Captured after pupil dilation:
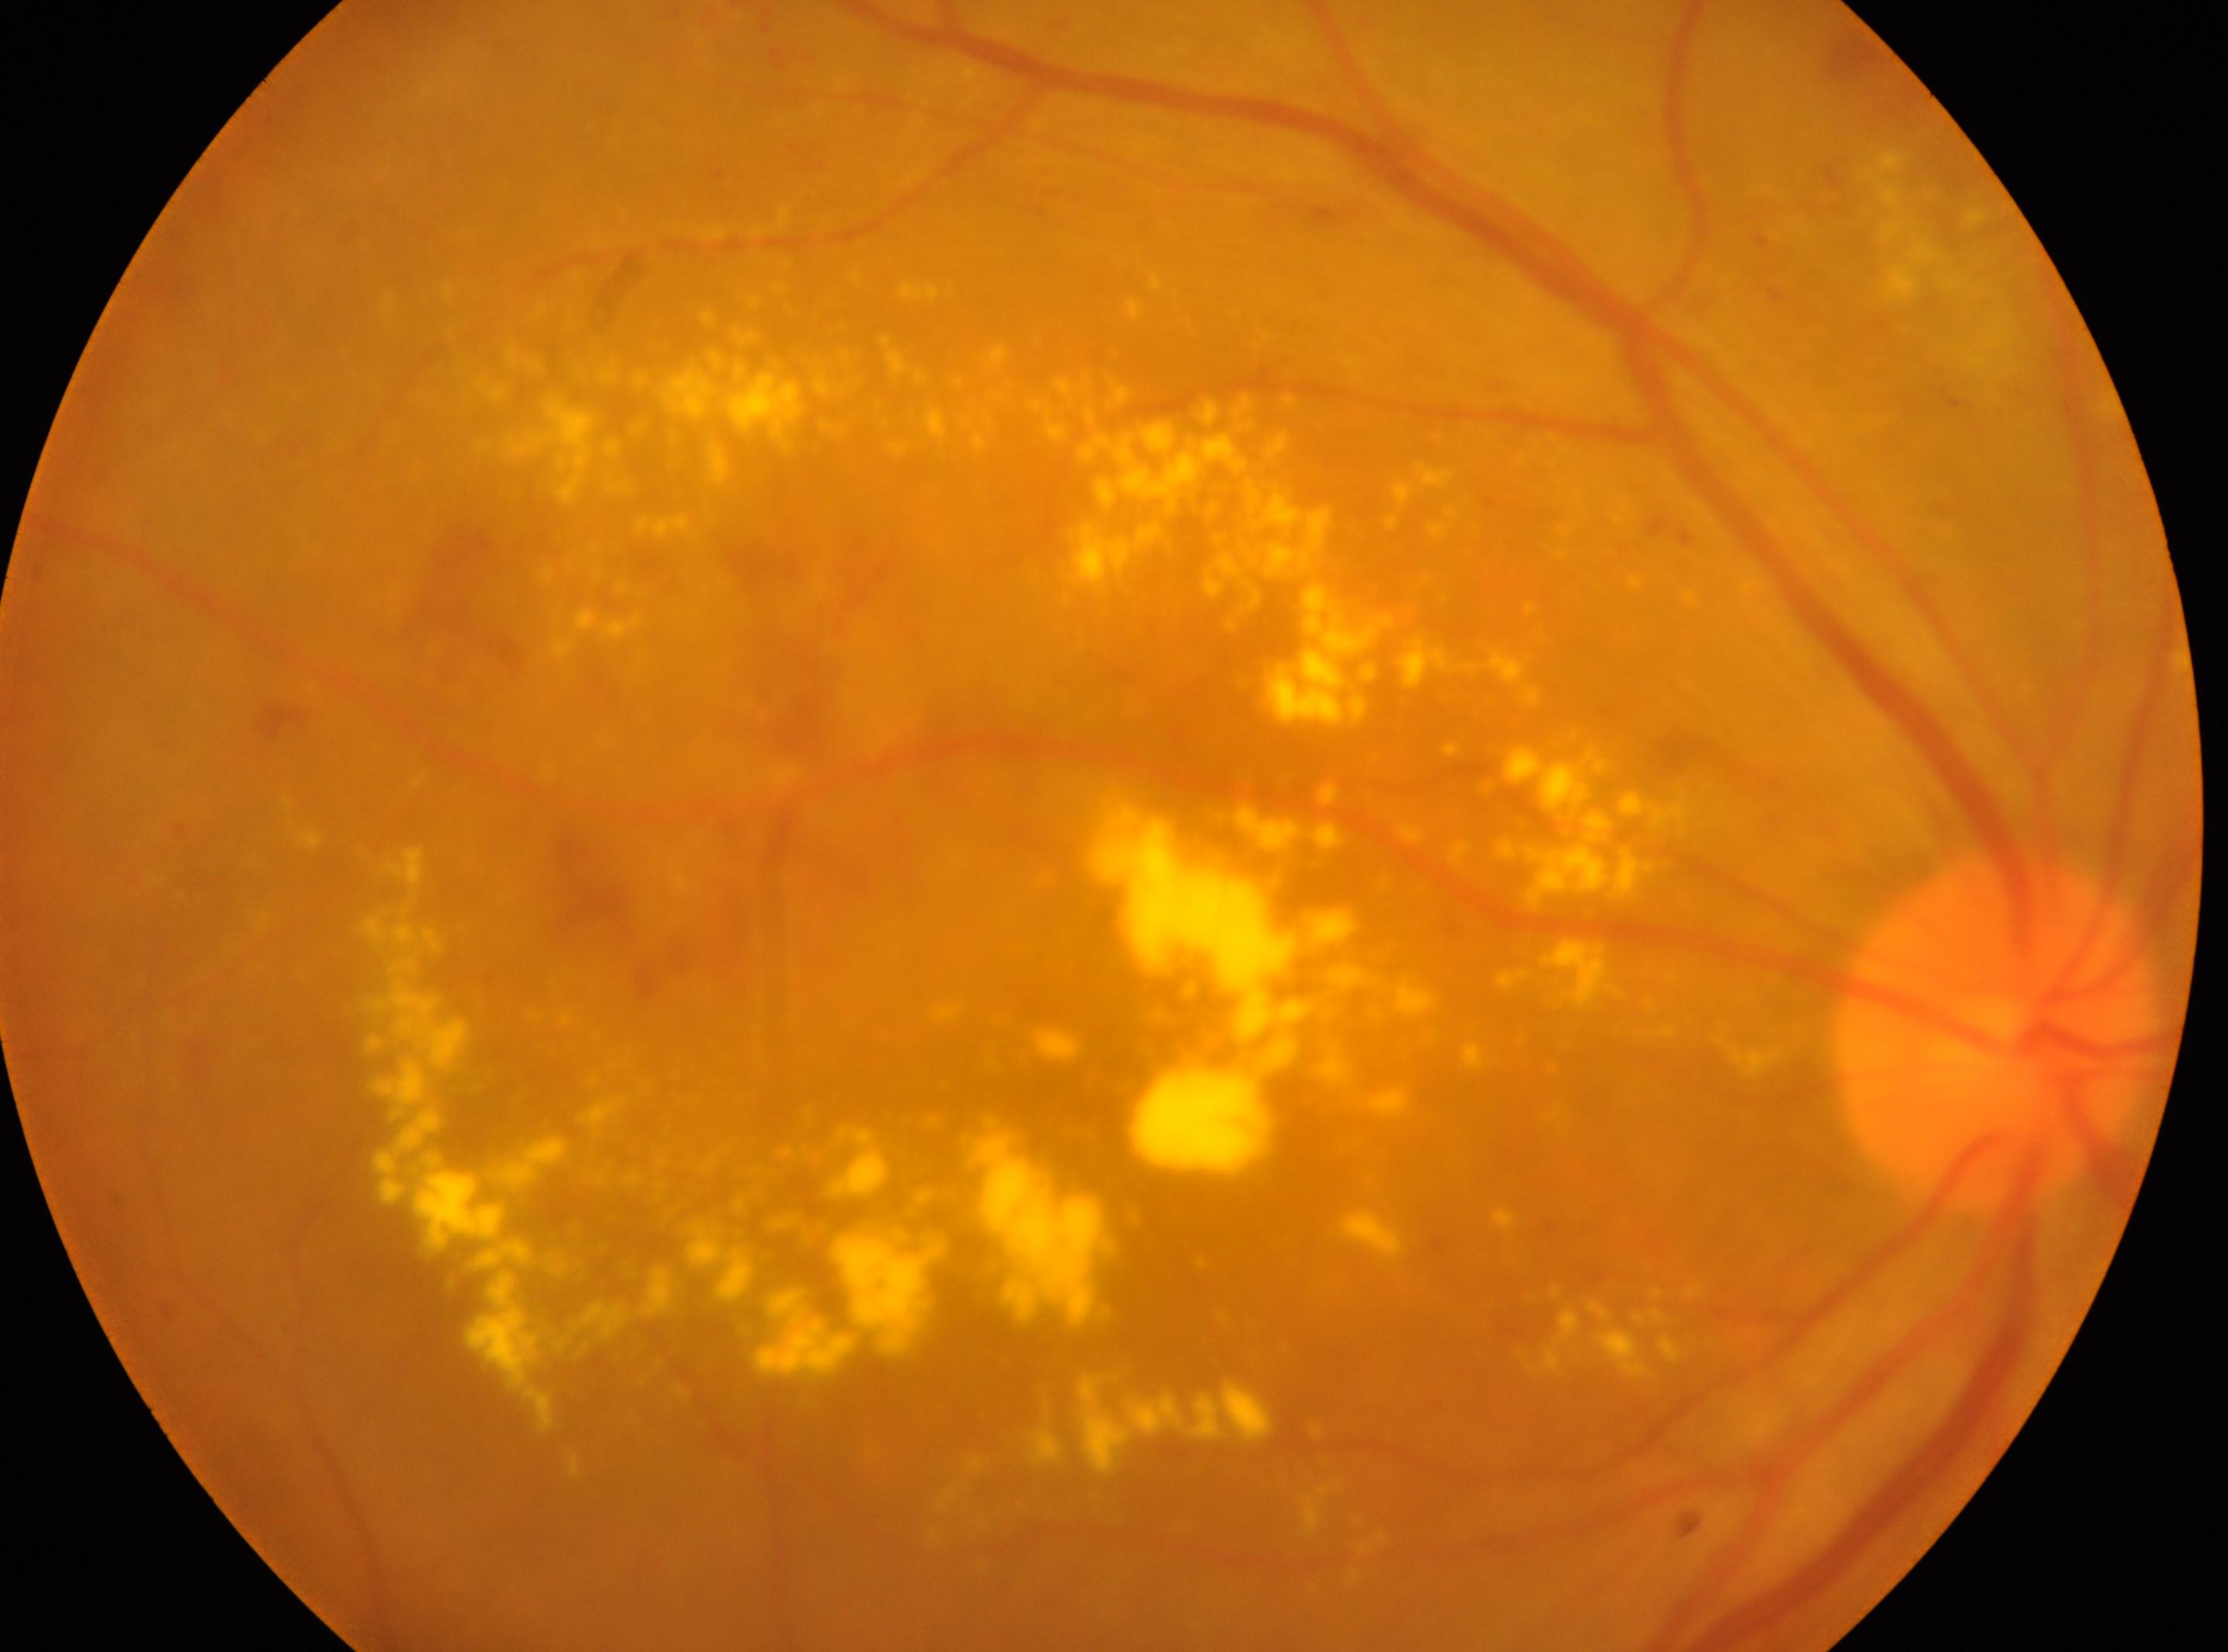 Imaged eye: right eye. The fovea center is at (x=1080, y=1063). Diabetic retinopathy severity is 2/4 — more than just microaneurysms but less than severe NPDR. Optic disc located at (x=1999, y=1035).